Davis DR grading · nonmydriatic fundus photograph · 848x848: 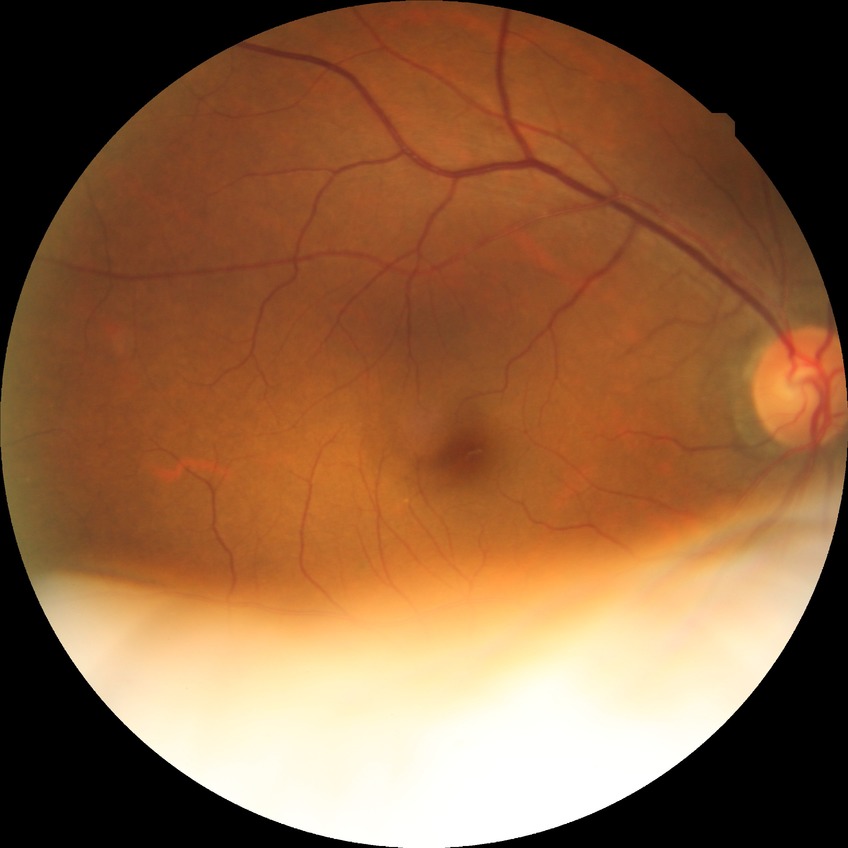 Diabetic retinopathy (DR) is NDR (no diabetic retinopathy).